FOV: 45 degrees. Color fundus image.
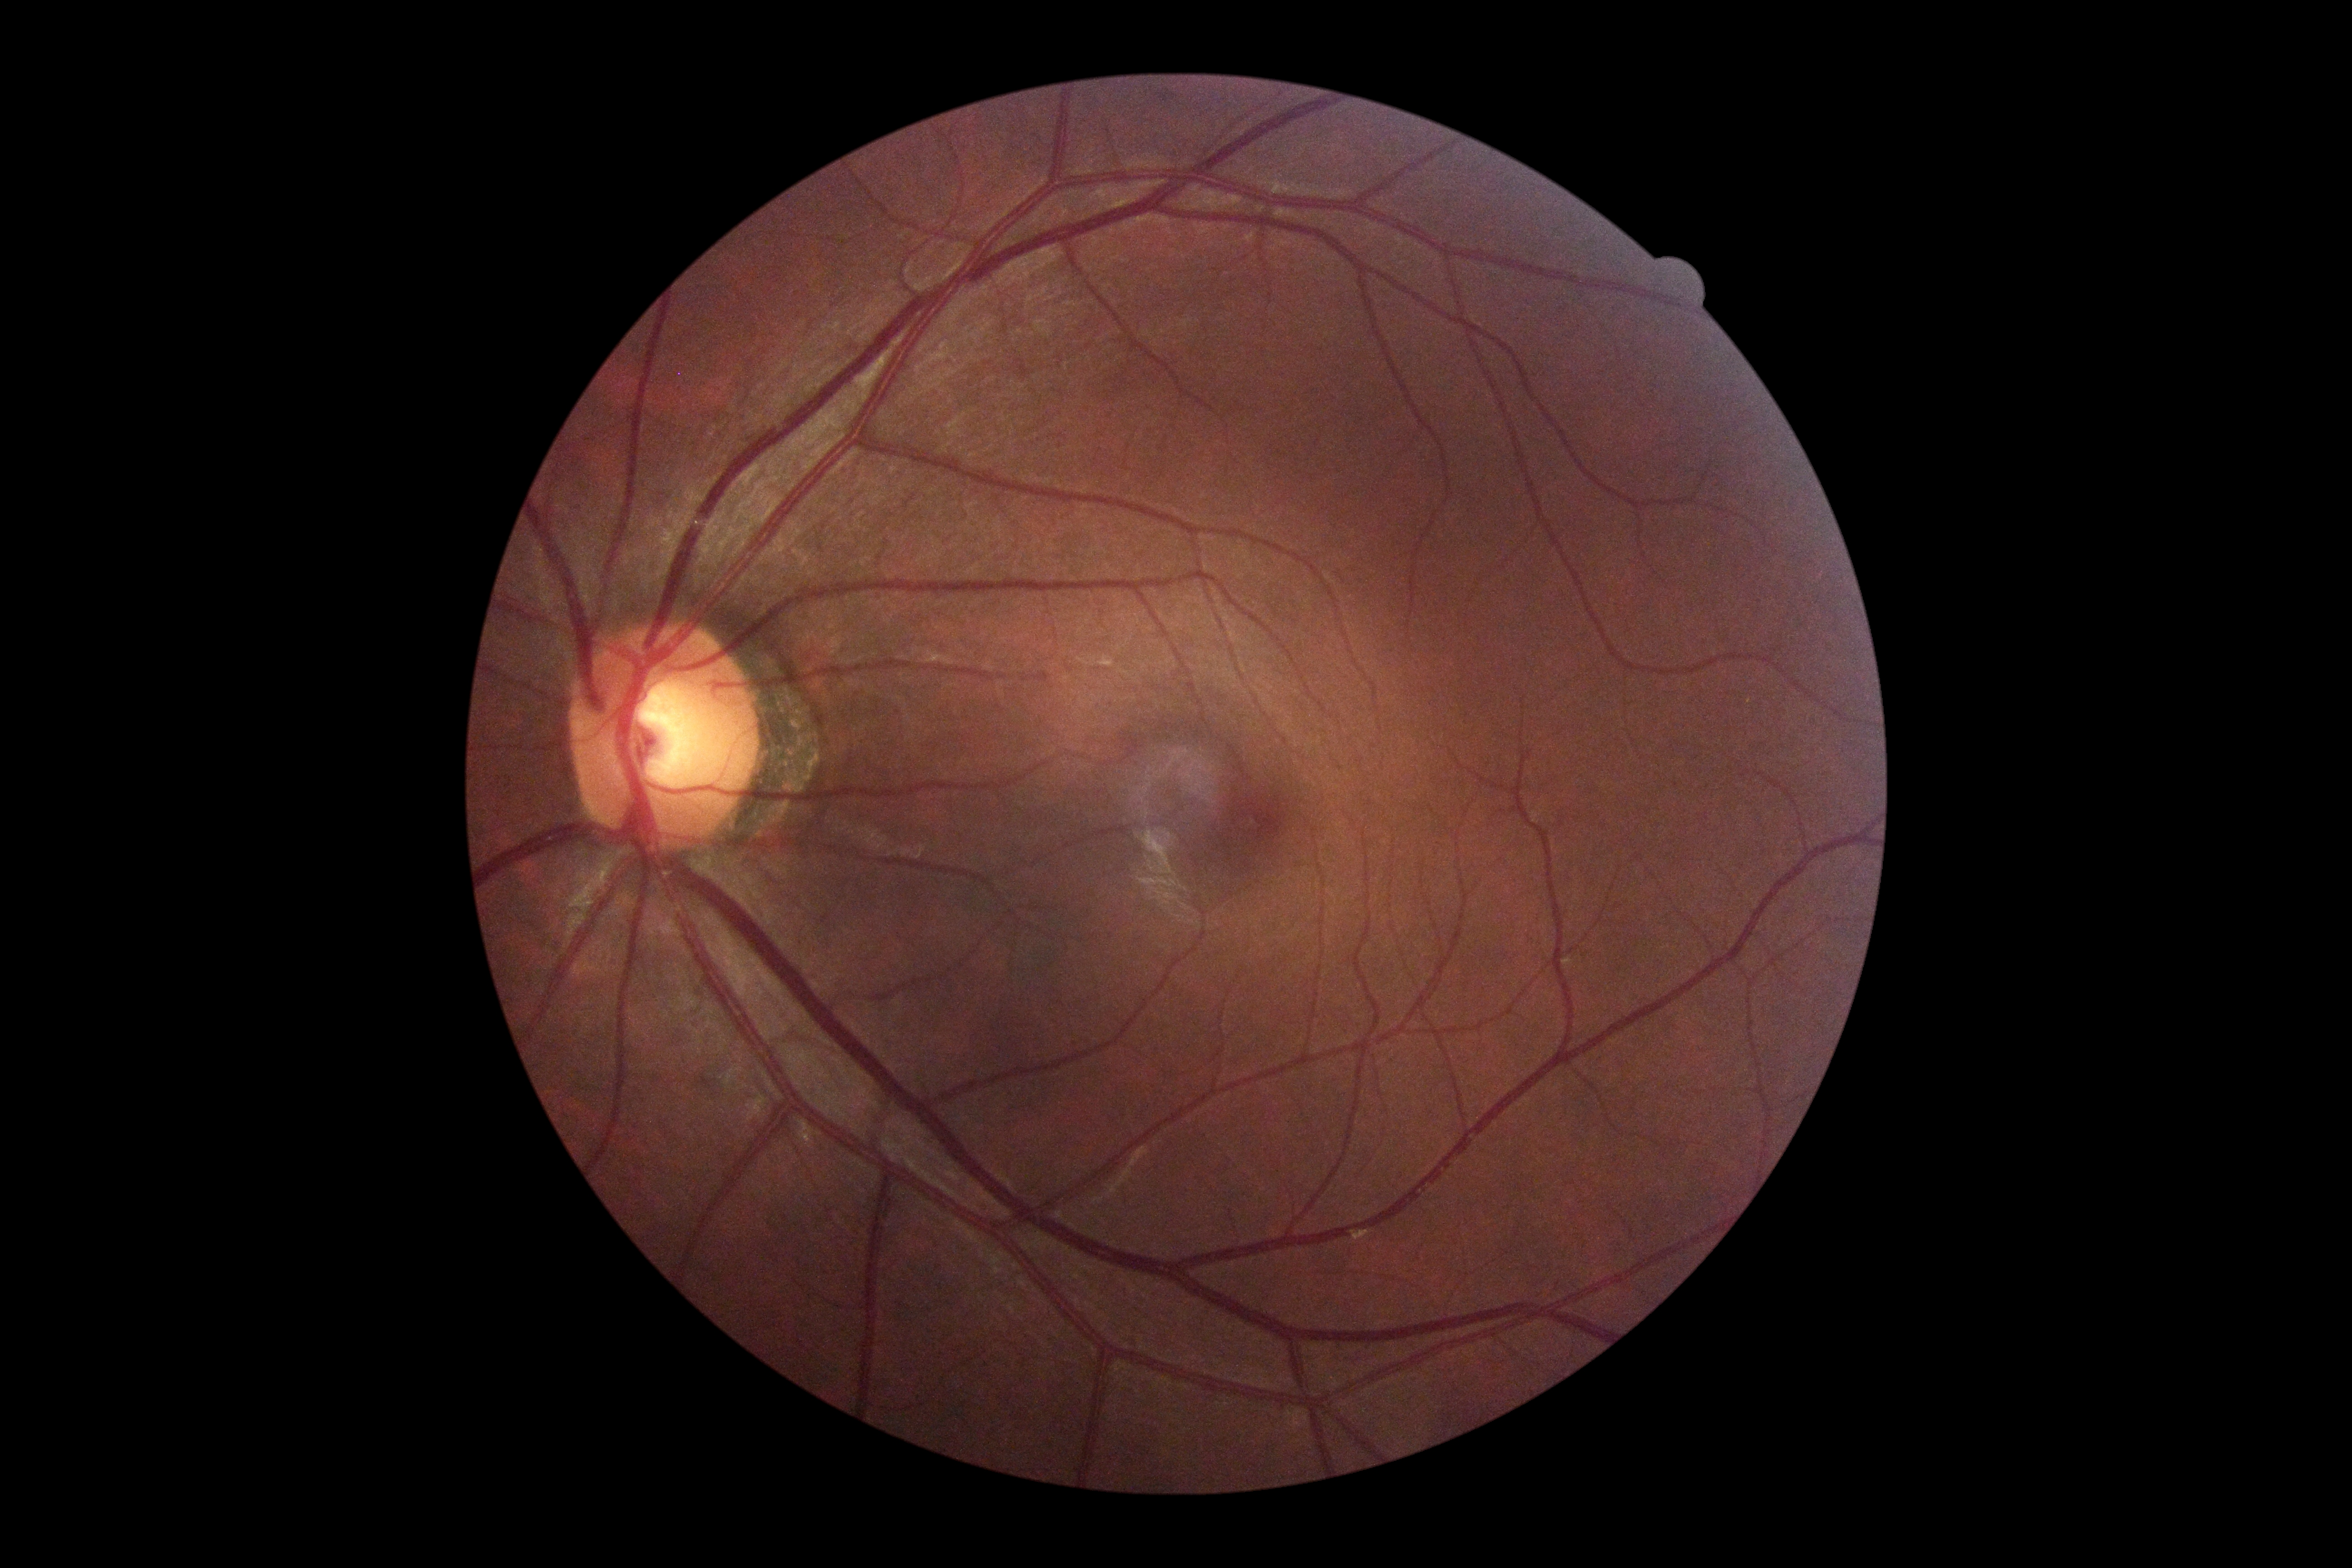 Retinopathy grade is 0 (no apparent retinopathy).